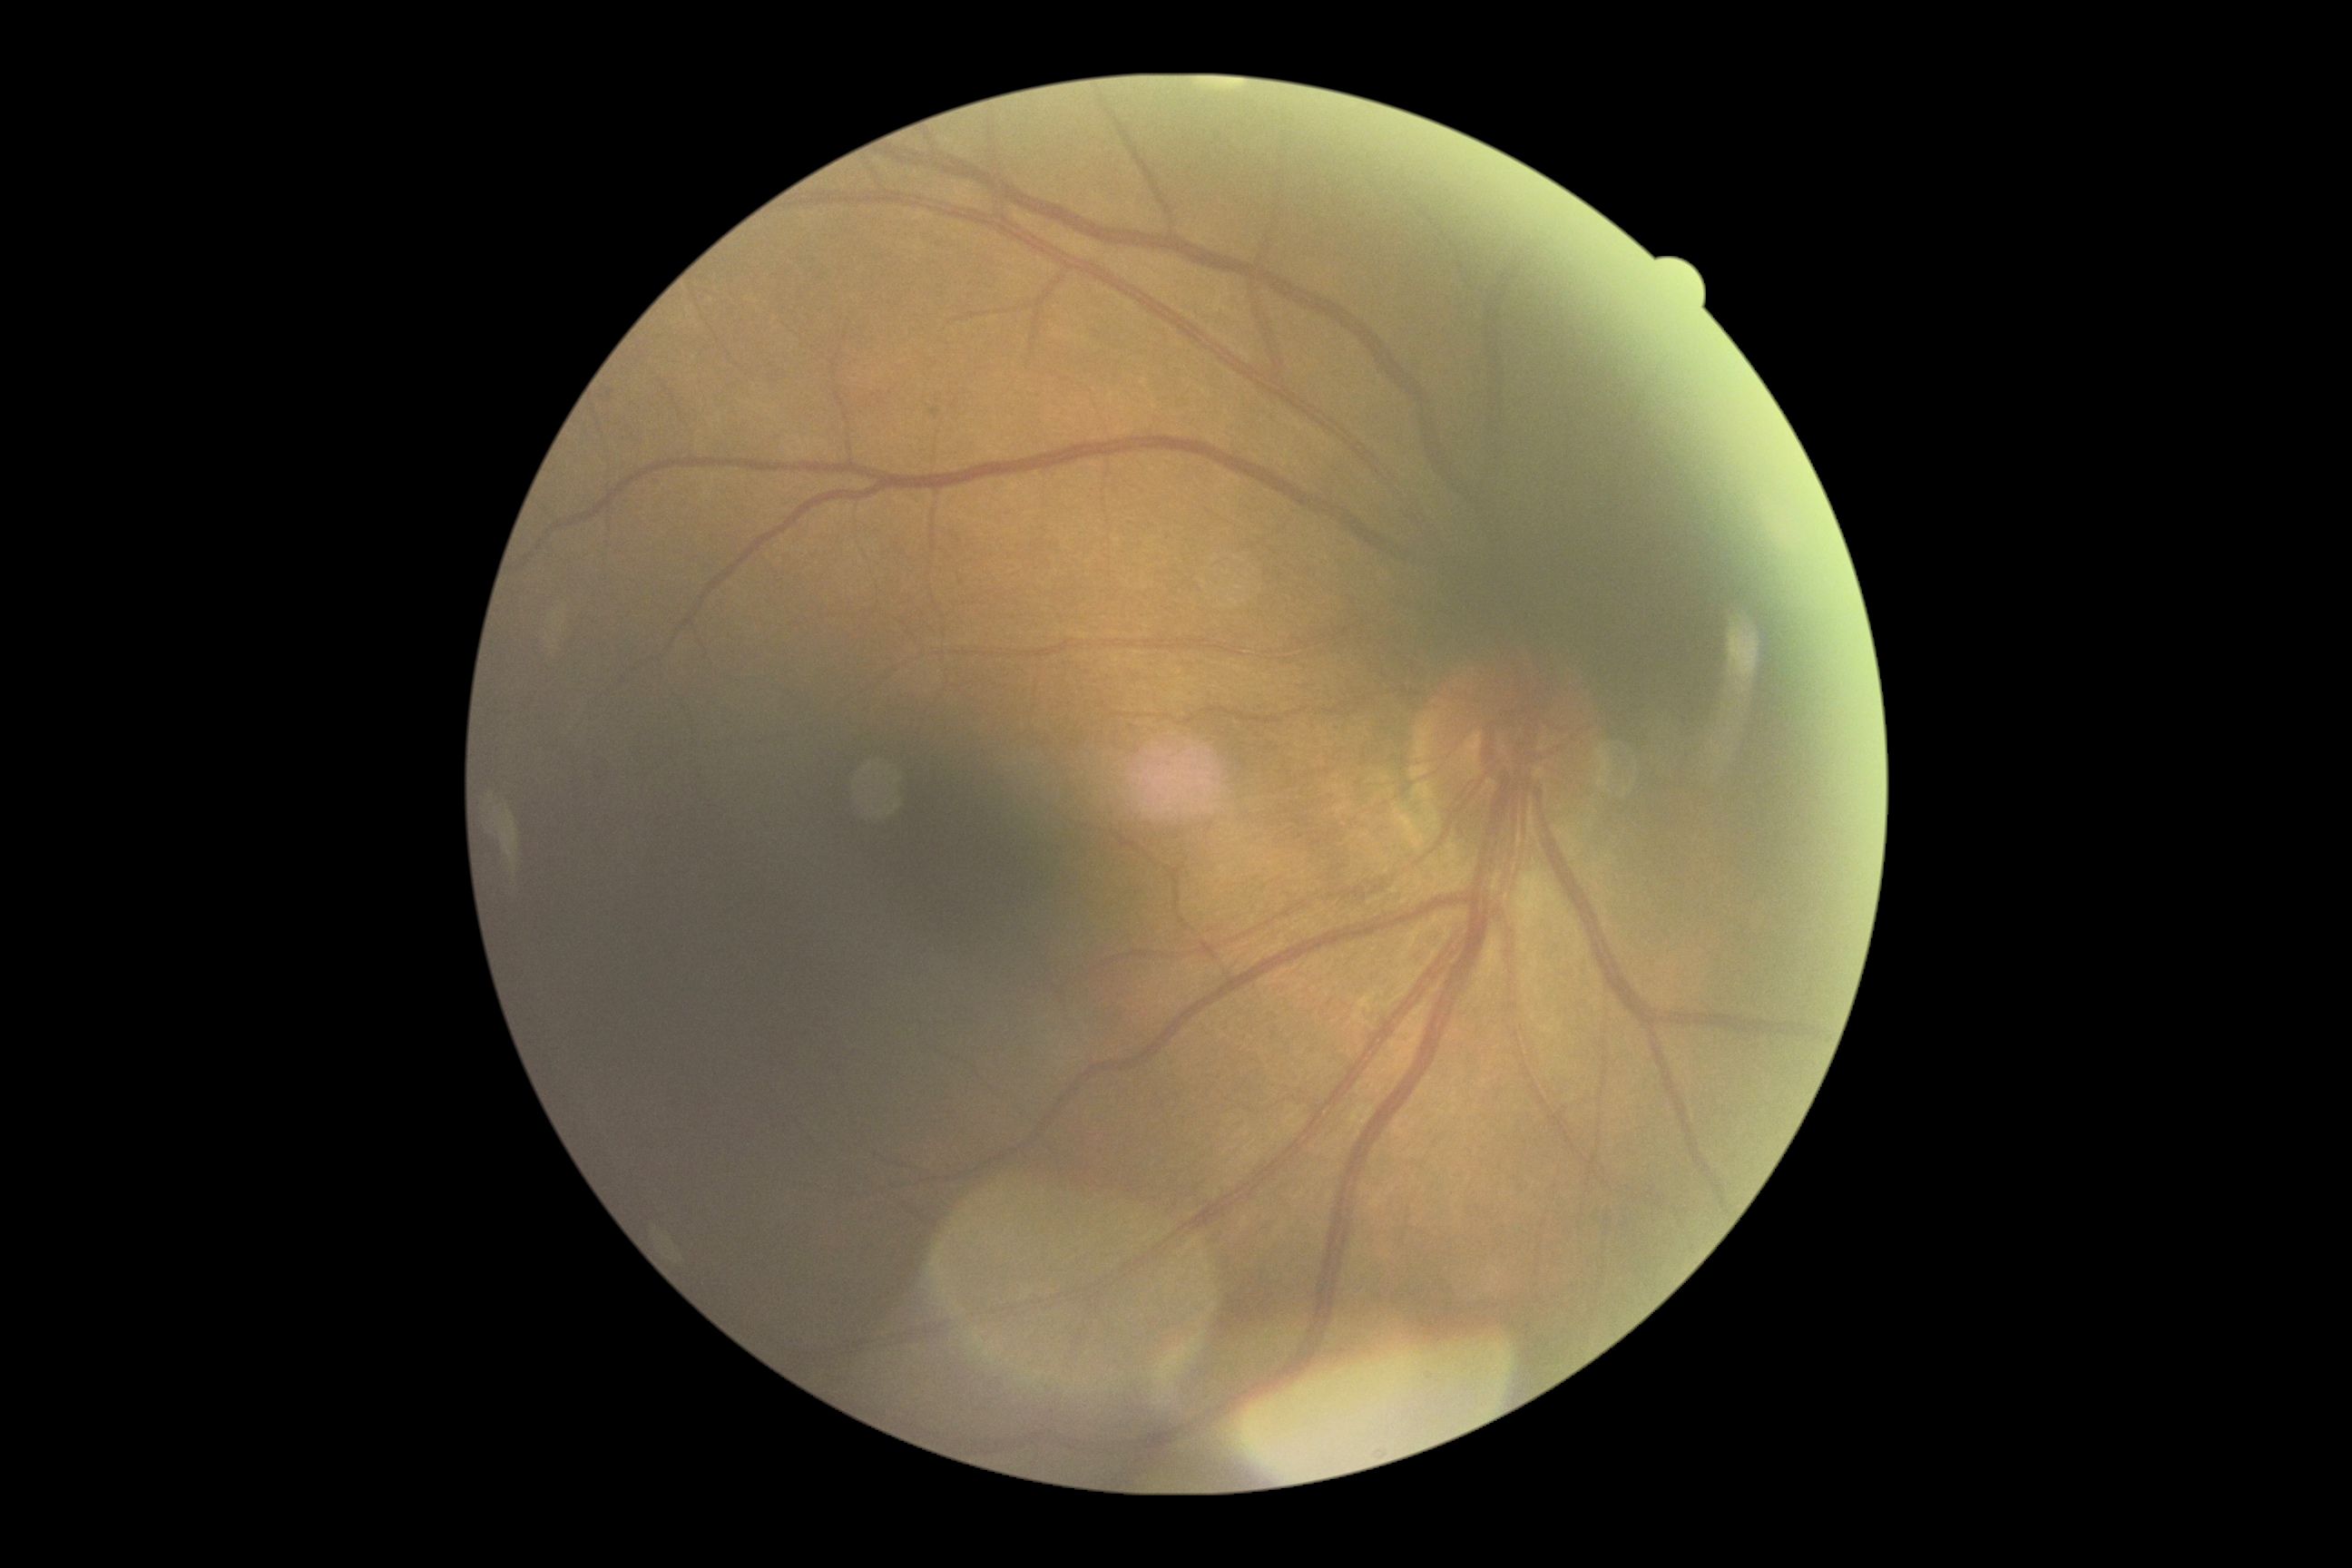
diabetic retinopathy grade: mild NPDR (1).